Acquired with a NIDEK AFC-230
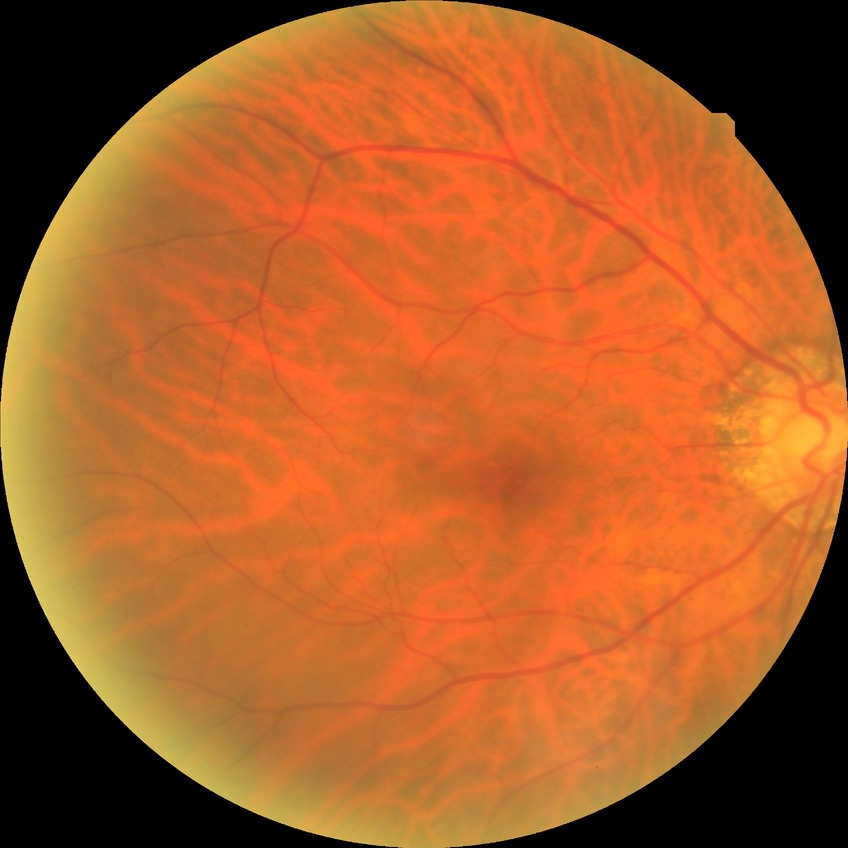

Diabetic retinopathy (DR): no diabetic retinopathy (NDR).